848x848px; 45 degree fundus photograph; retinal fundus photograph.
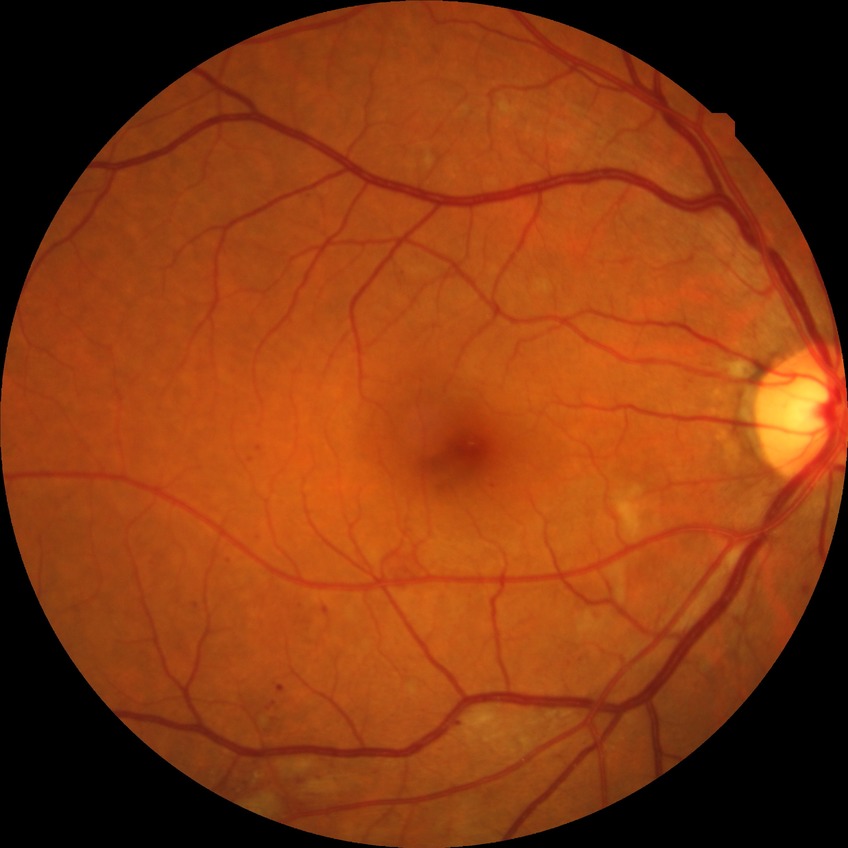

proliferative_class: non-proliferative diabetic retinopathy
davis_grade: PPDR (pre-proliferative diabetic retinopathy)